Diabetic retinopathy graded by the modified Davis classification — 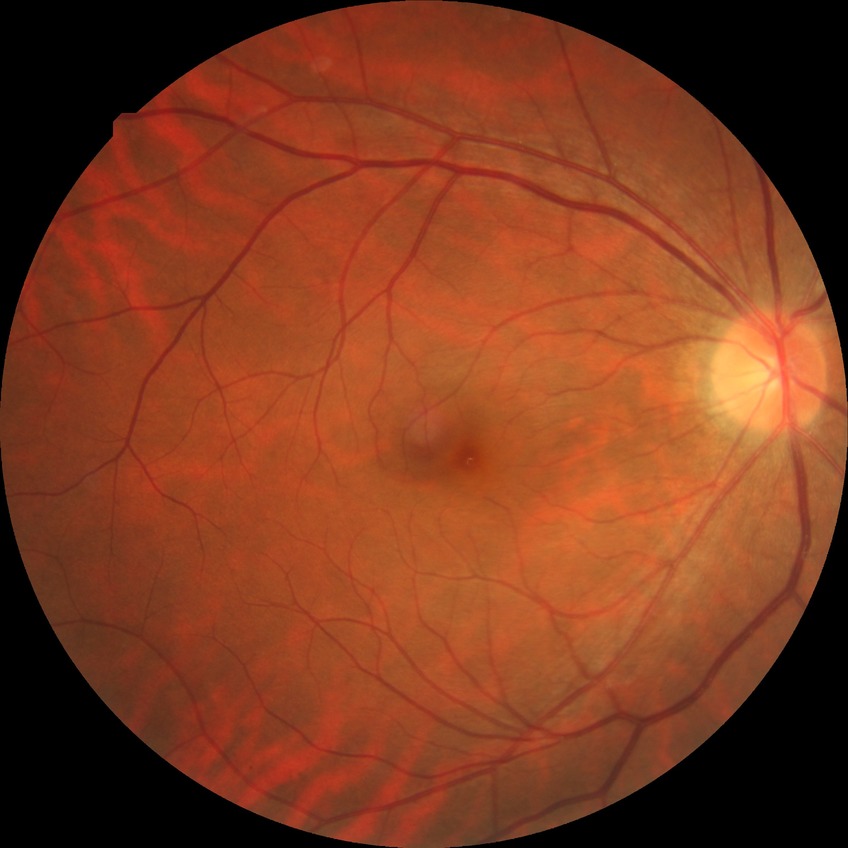
{
  "davis_grade": "no diabetic retinopathy"
}